Wide-field fundus photograph from neonatal ROP screening: 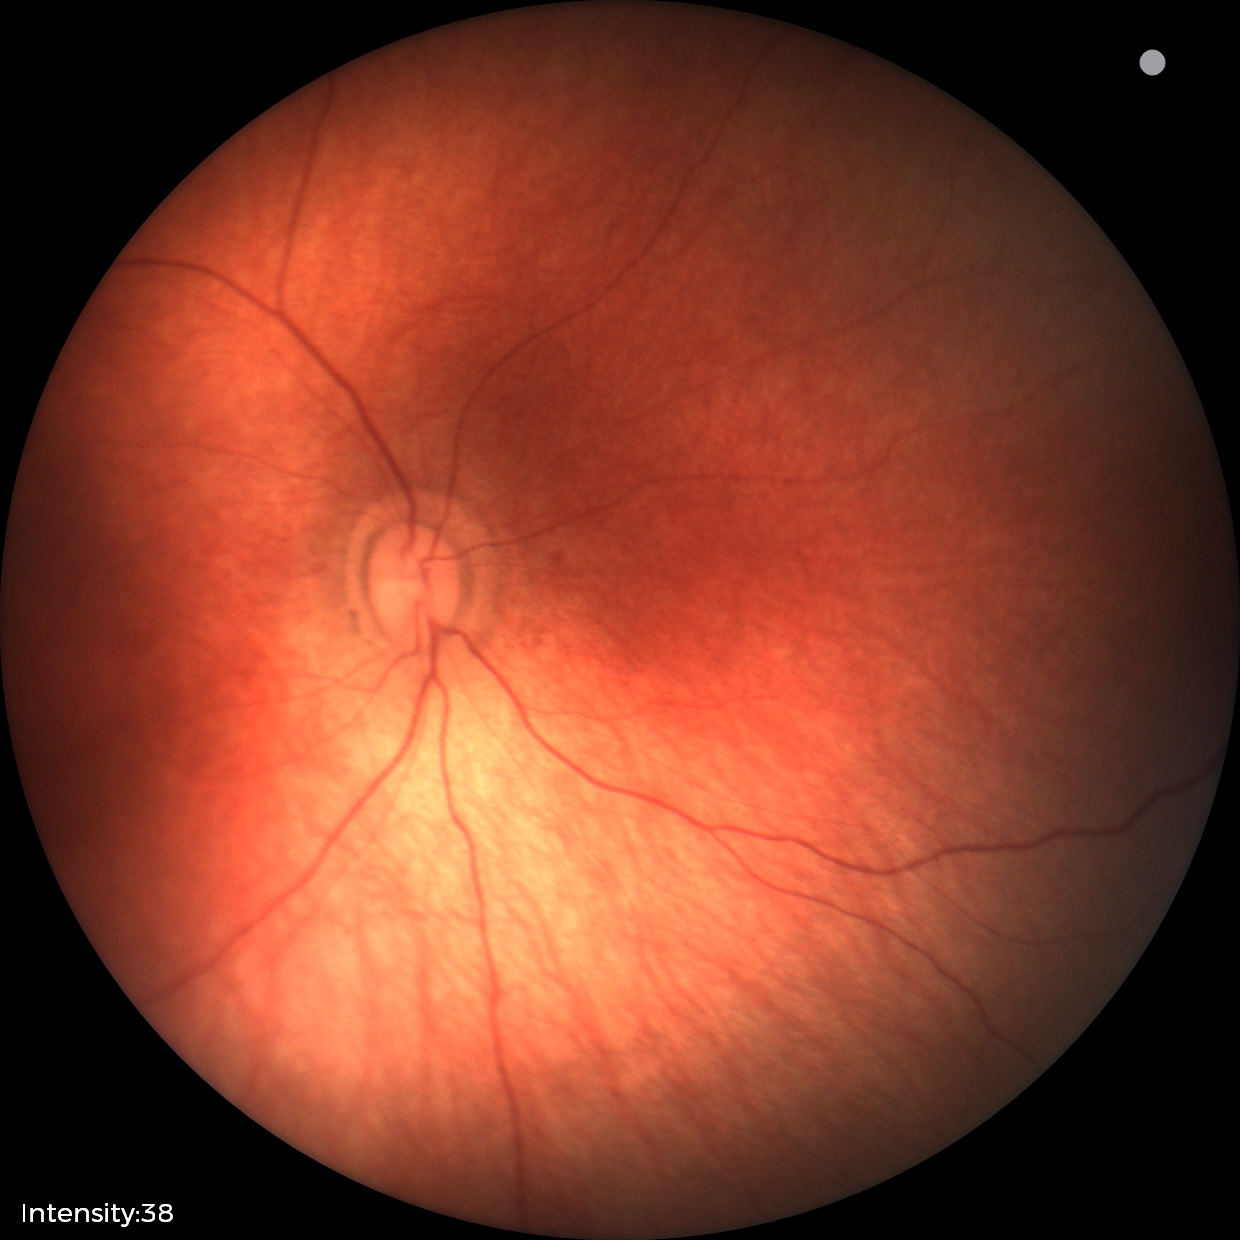
Assessment: physiological appearance with no retinal pathology.